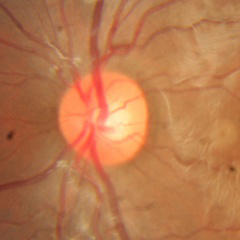 Q: Does this eye have glaucoma?
A: No glaucoma.